Diabetic retinopathy graded by the modified Davis classification
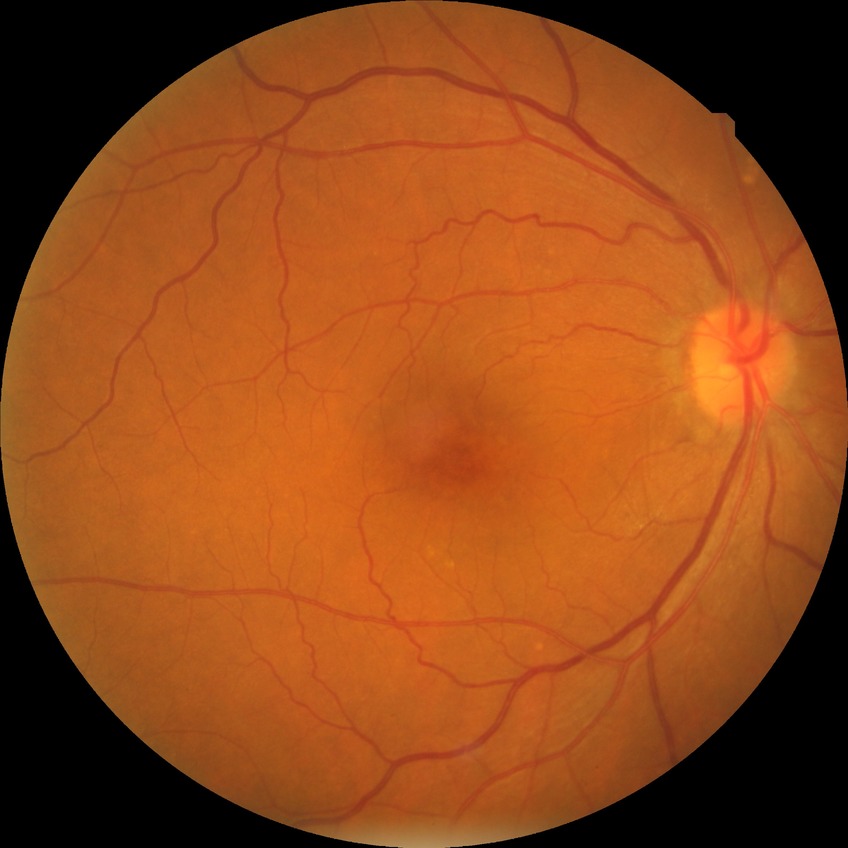
Retinopathy stage: no diabetic retinopathy.